Captured on a Remidio Fundus on Phone (FOP) camera: 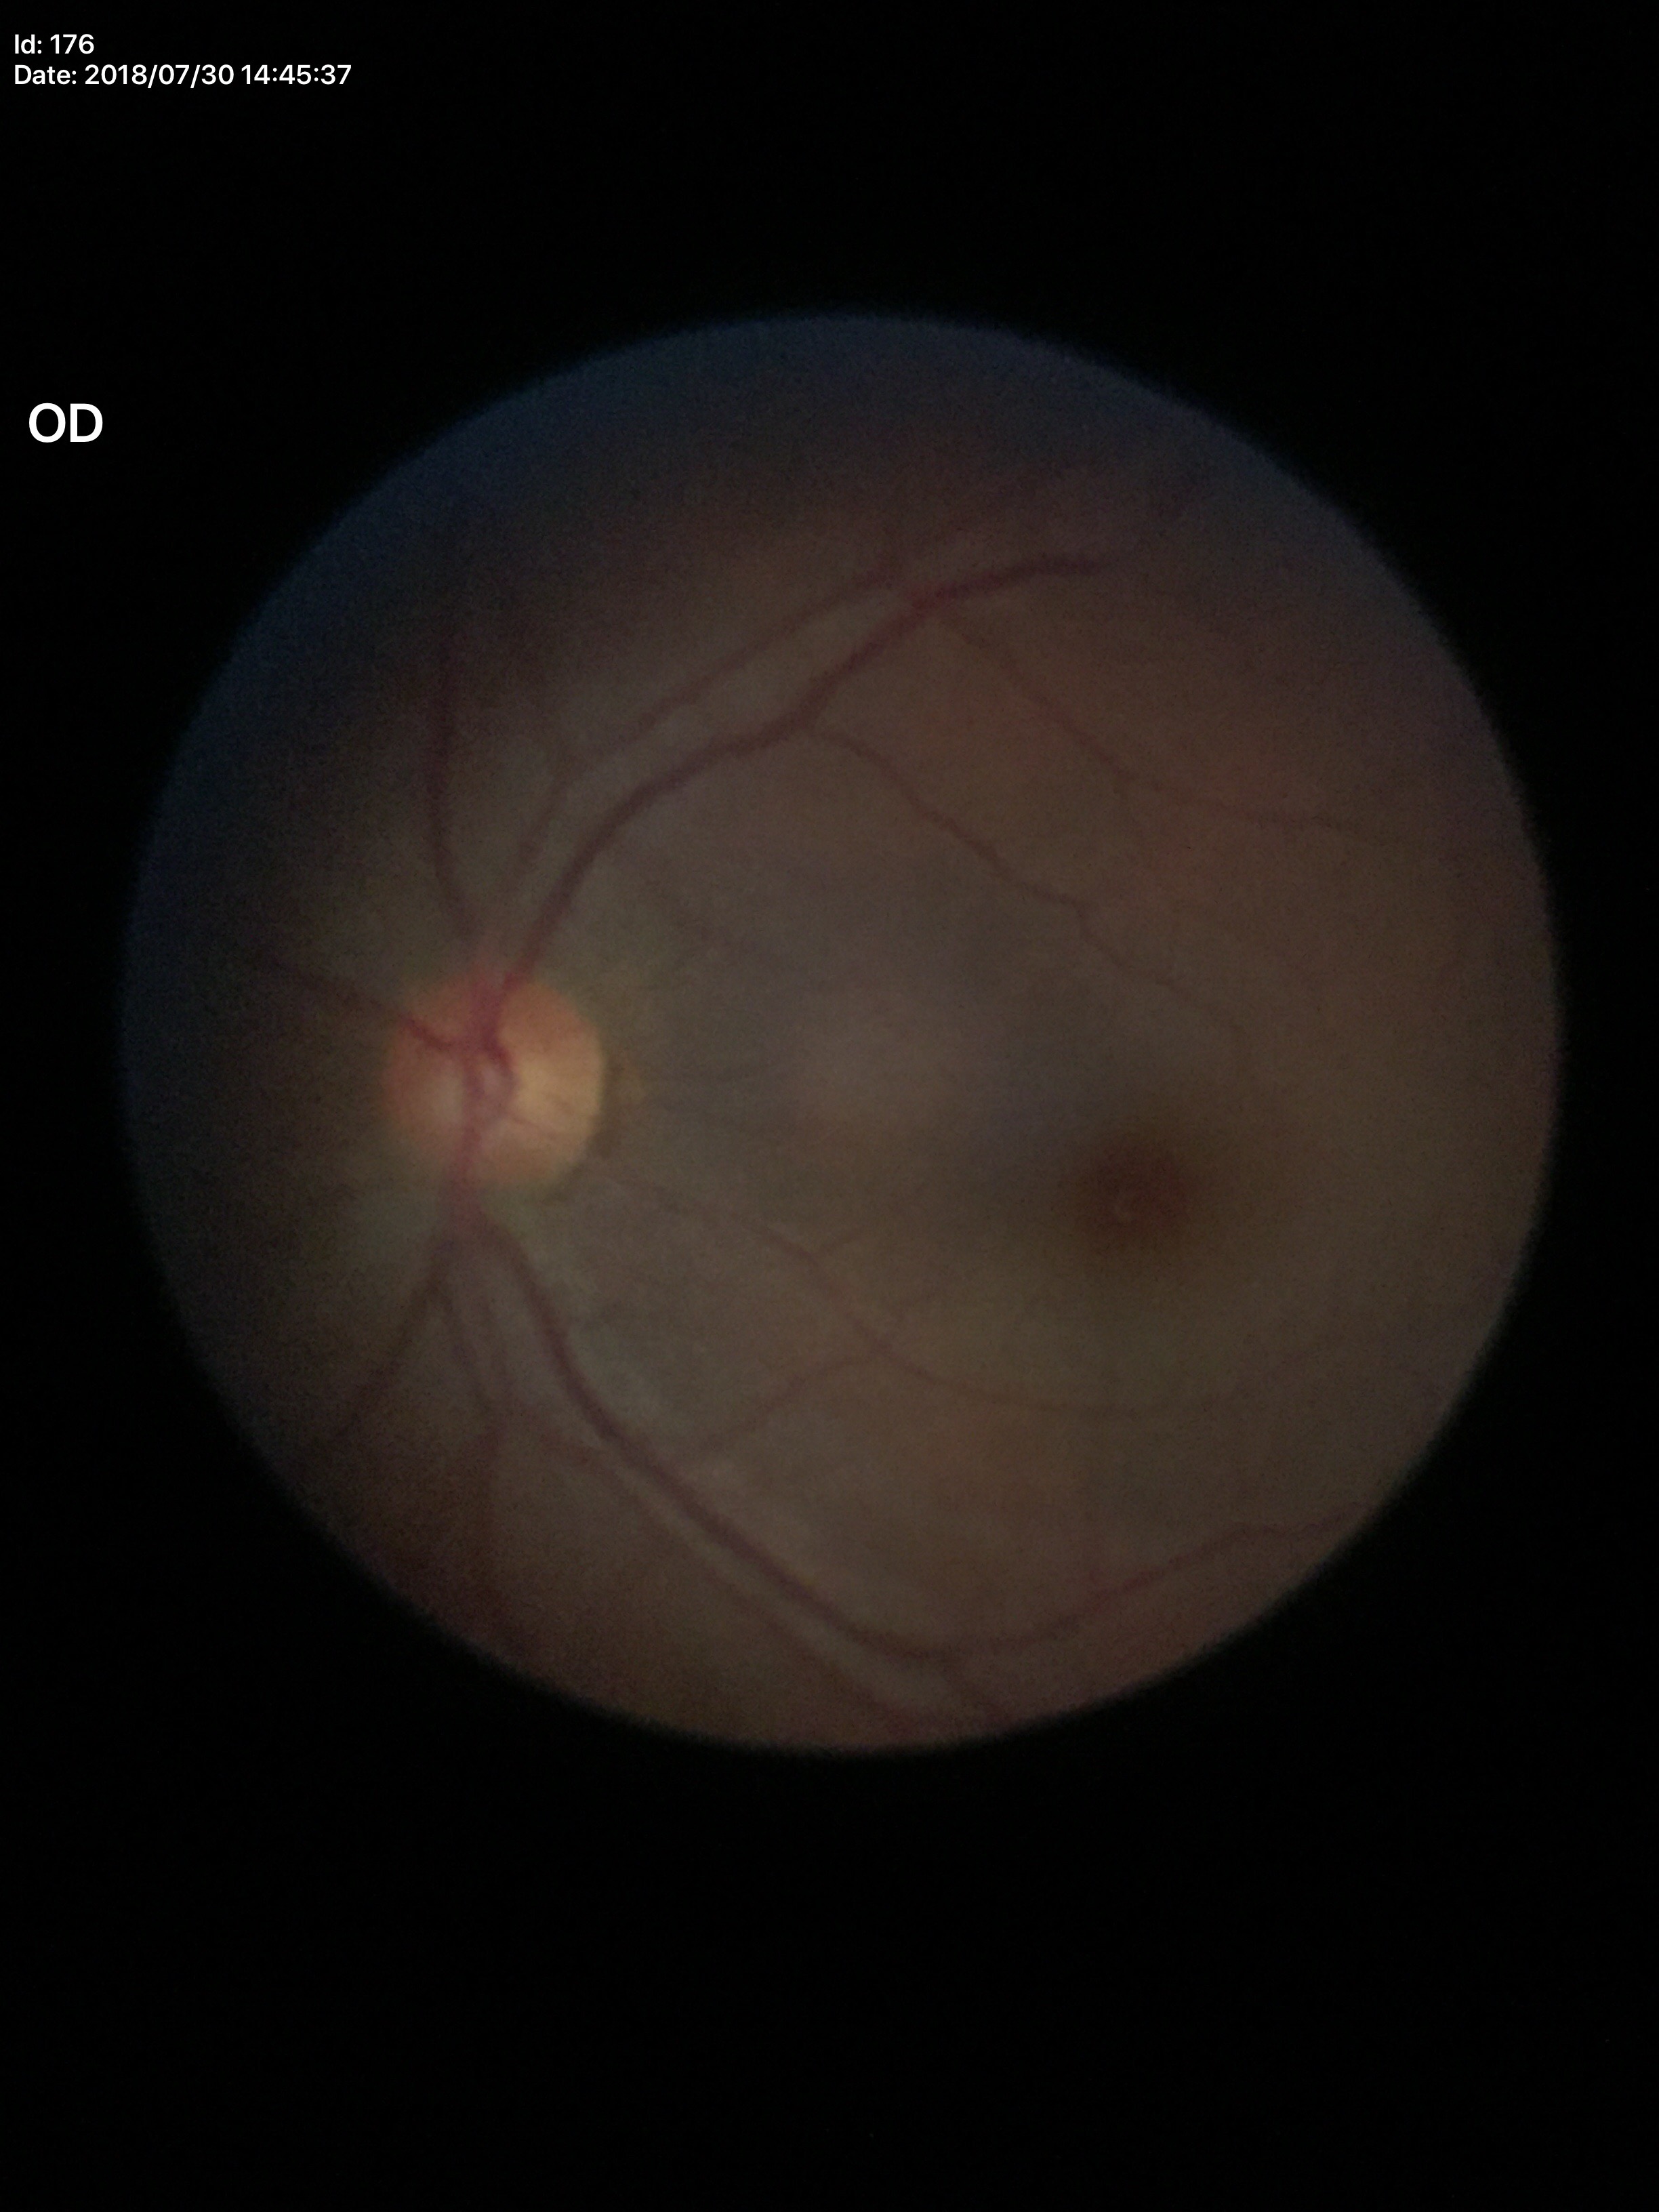

Area C/D ratio (ACDR): 0.26.
Vertical cup-to-disc ratio (VCDR): 0.51.
Glaucoma impression: negative.